Color fundus photograph, 1380x1382, 45° FOV: 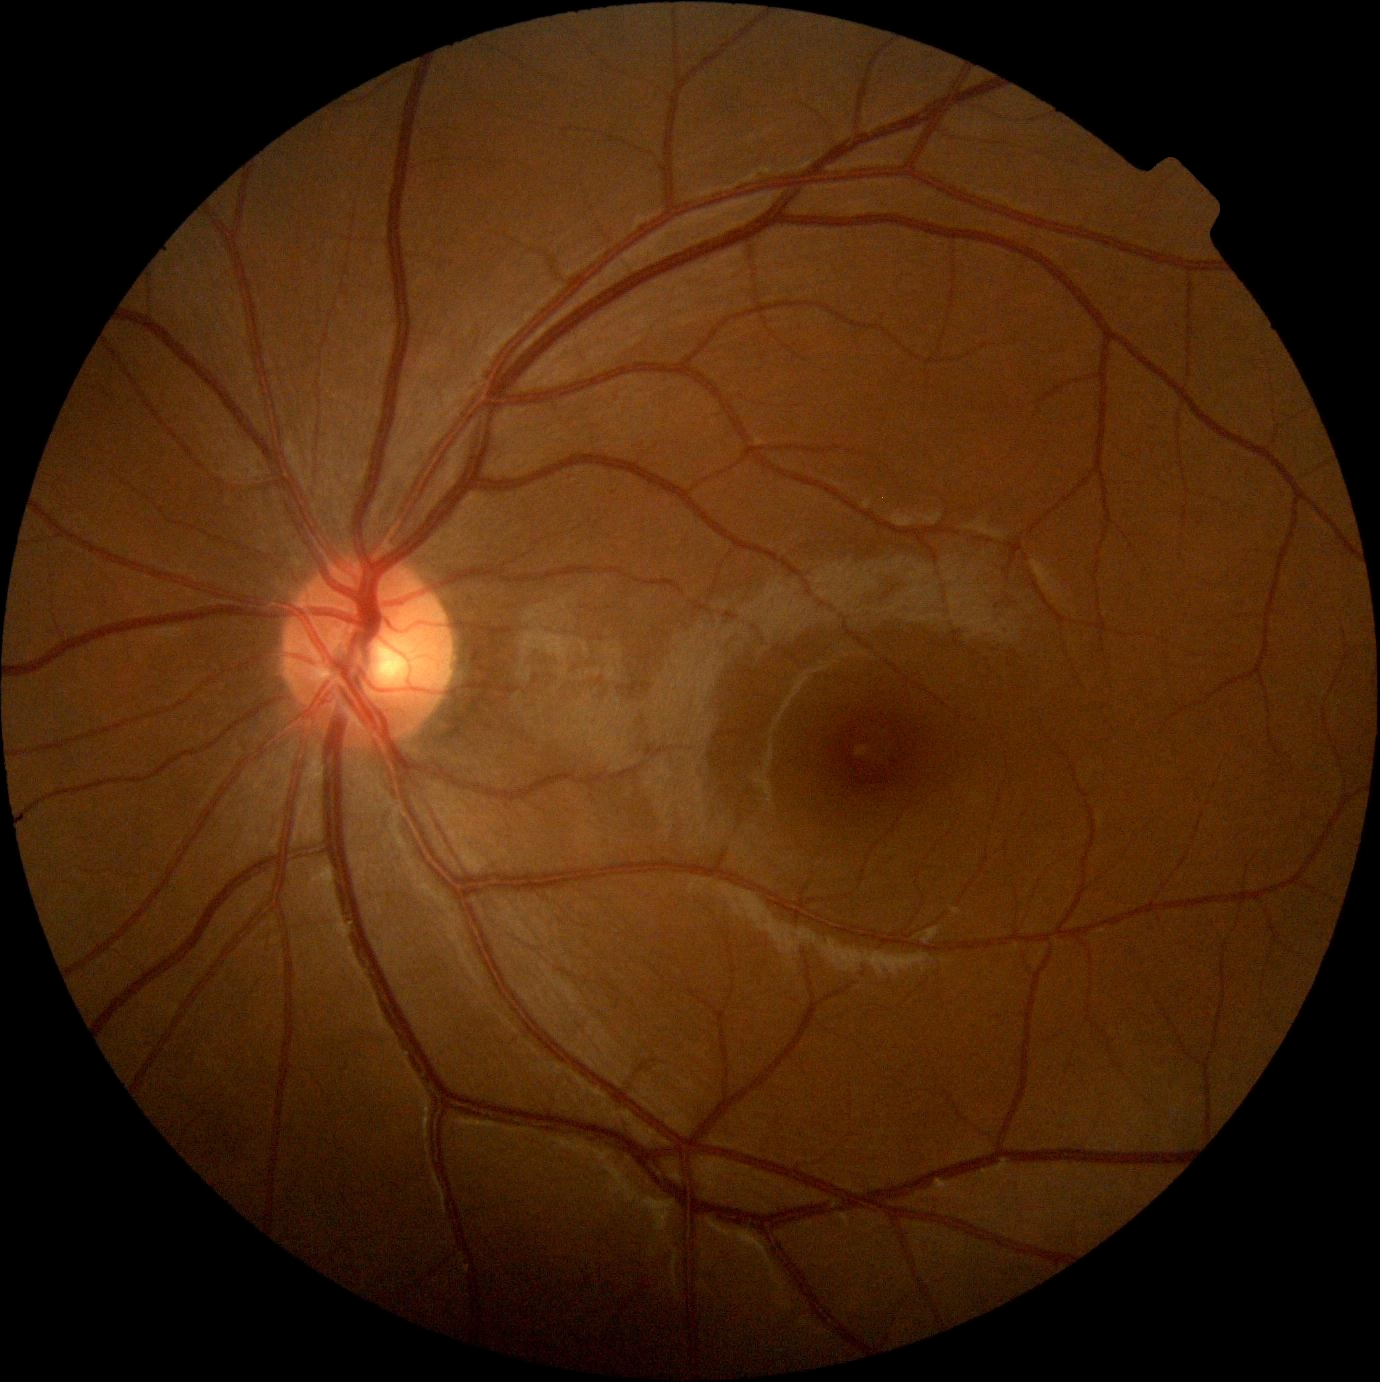

DR stage: no apparent diabetic retinopathy (grade 0).